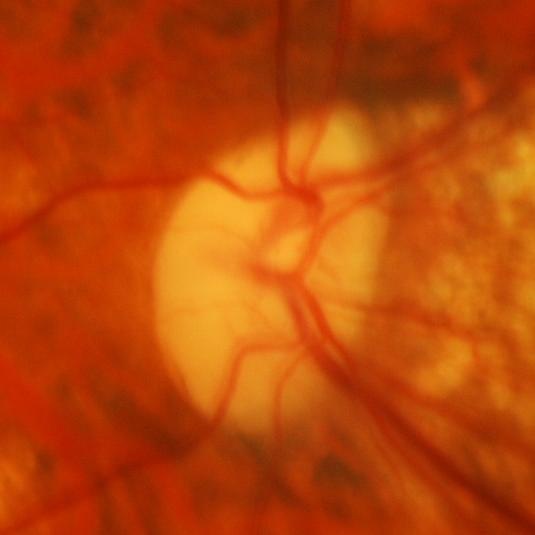
ONH-centered fundus image showing glaucomatous changes.